Wide-field fundus image from infant ROP screening — 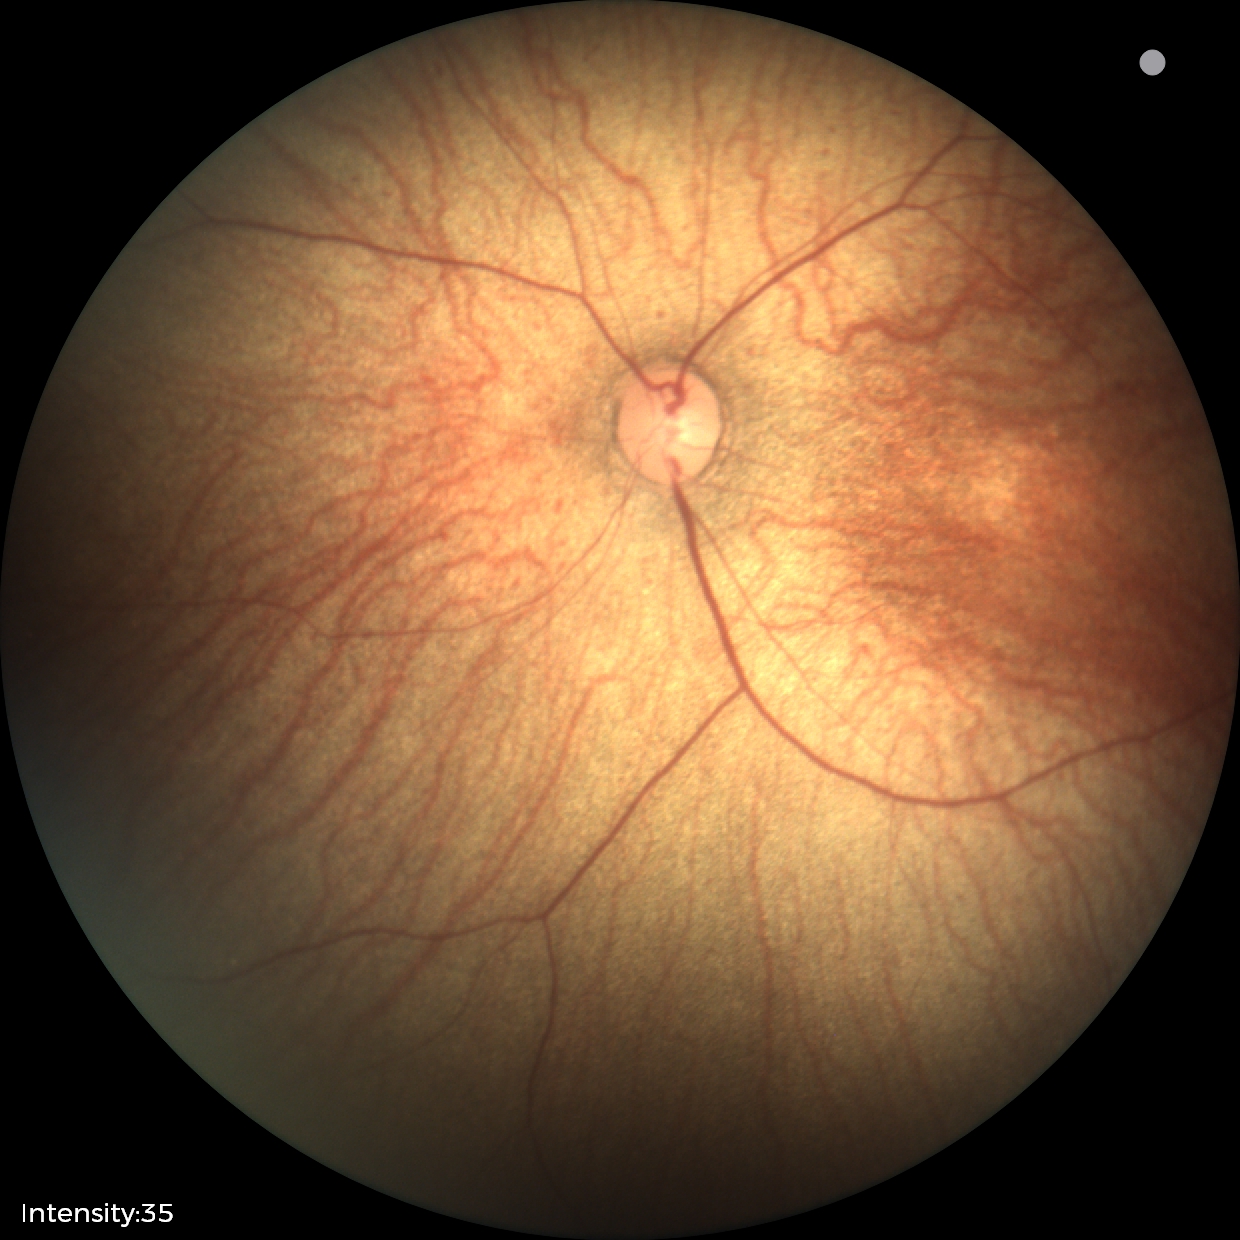 Screening examination diagnosed as physiological.